CFP · 2352x1568 · 45-degree field of view — 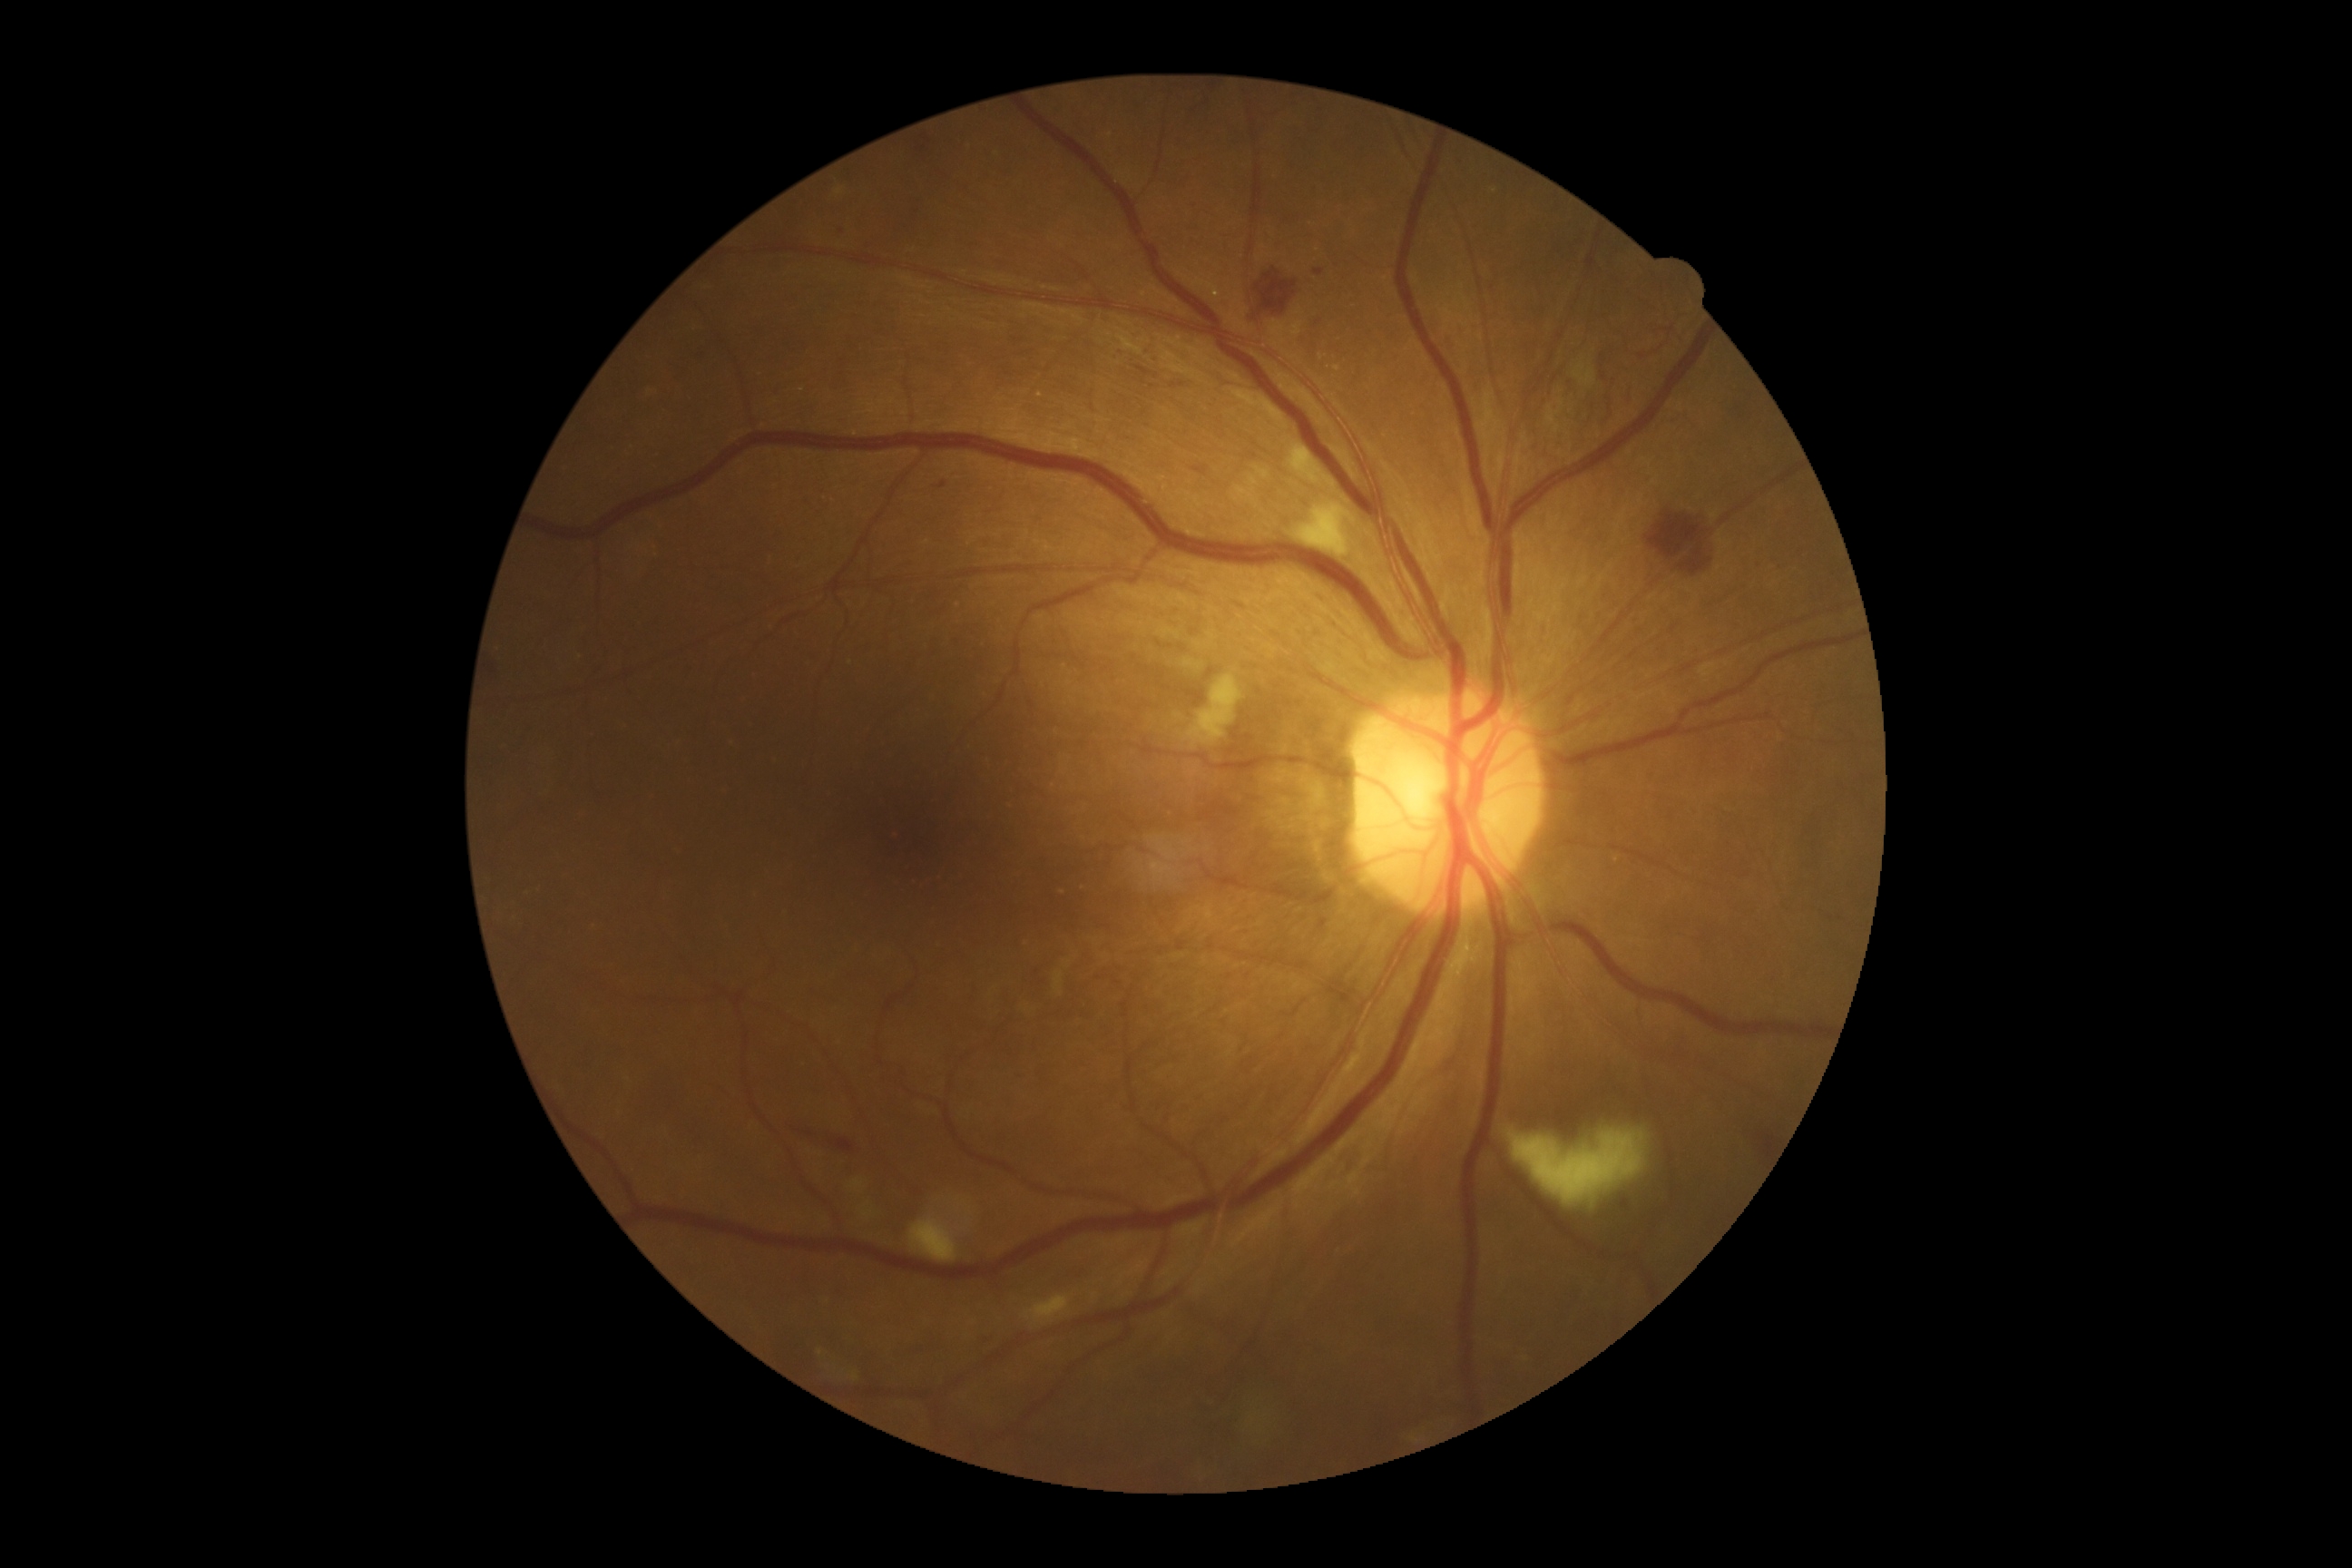

diabetic retinopathy@2.